2352x1568px. CFP — 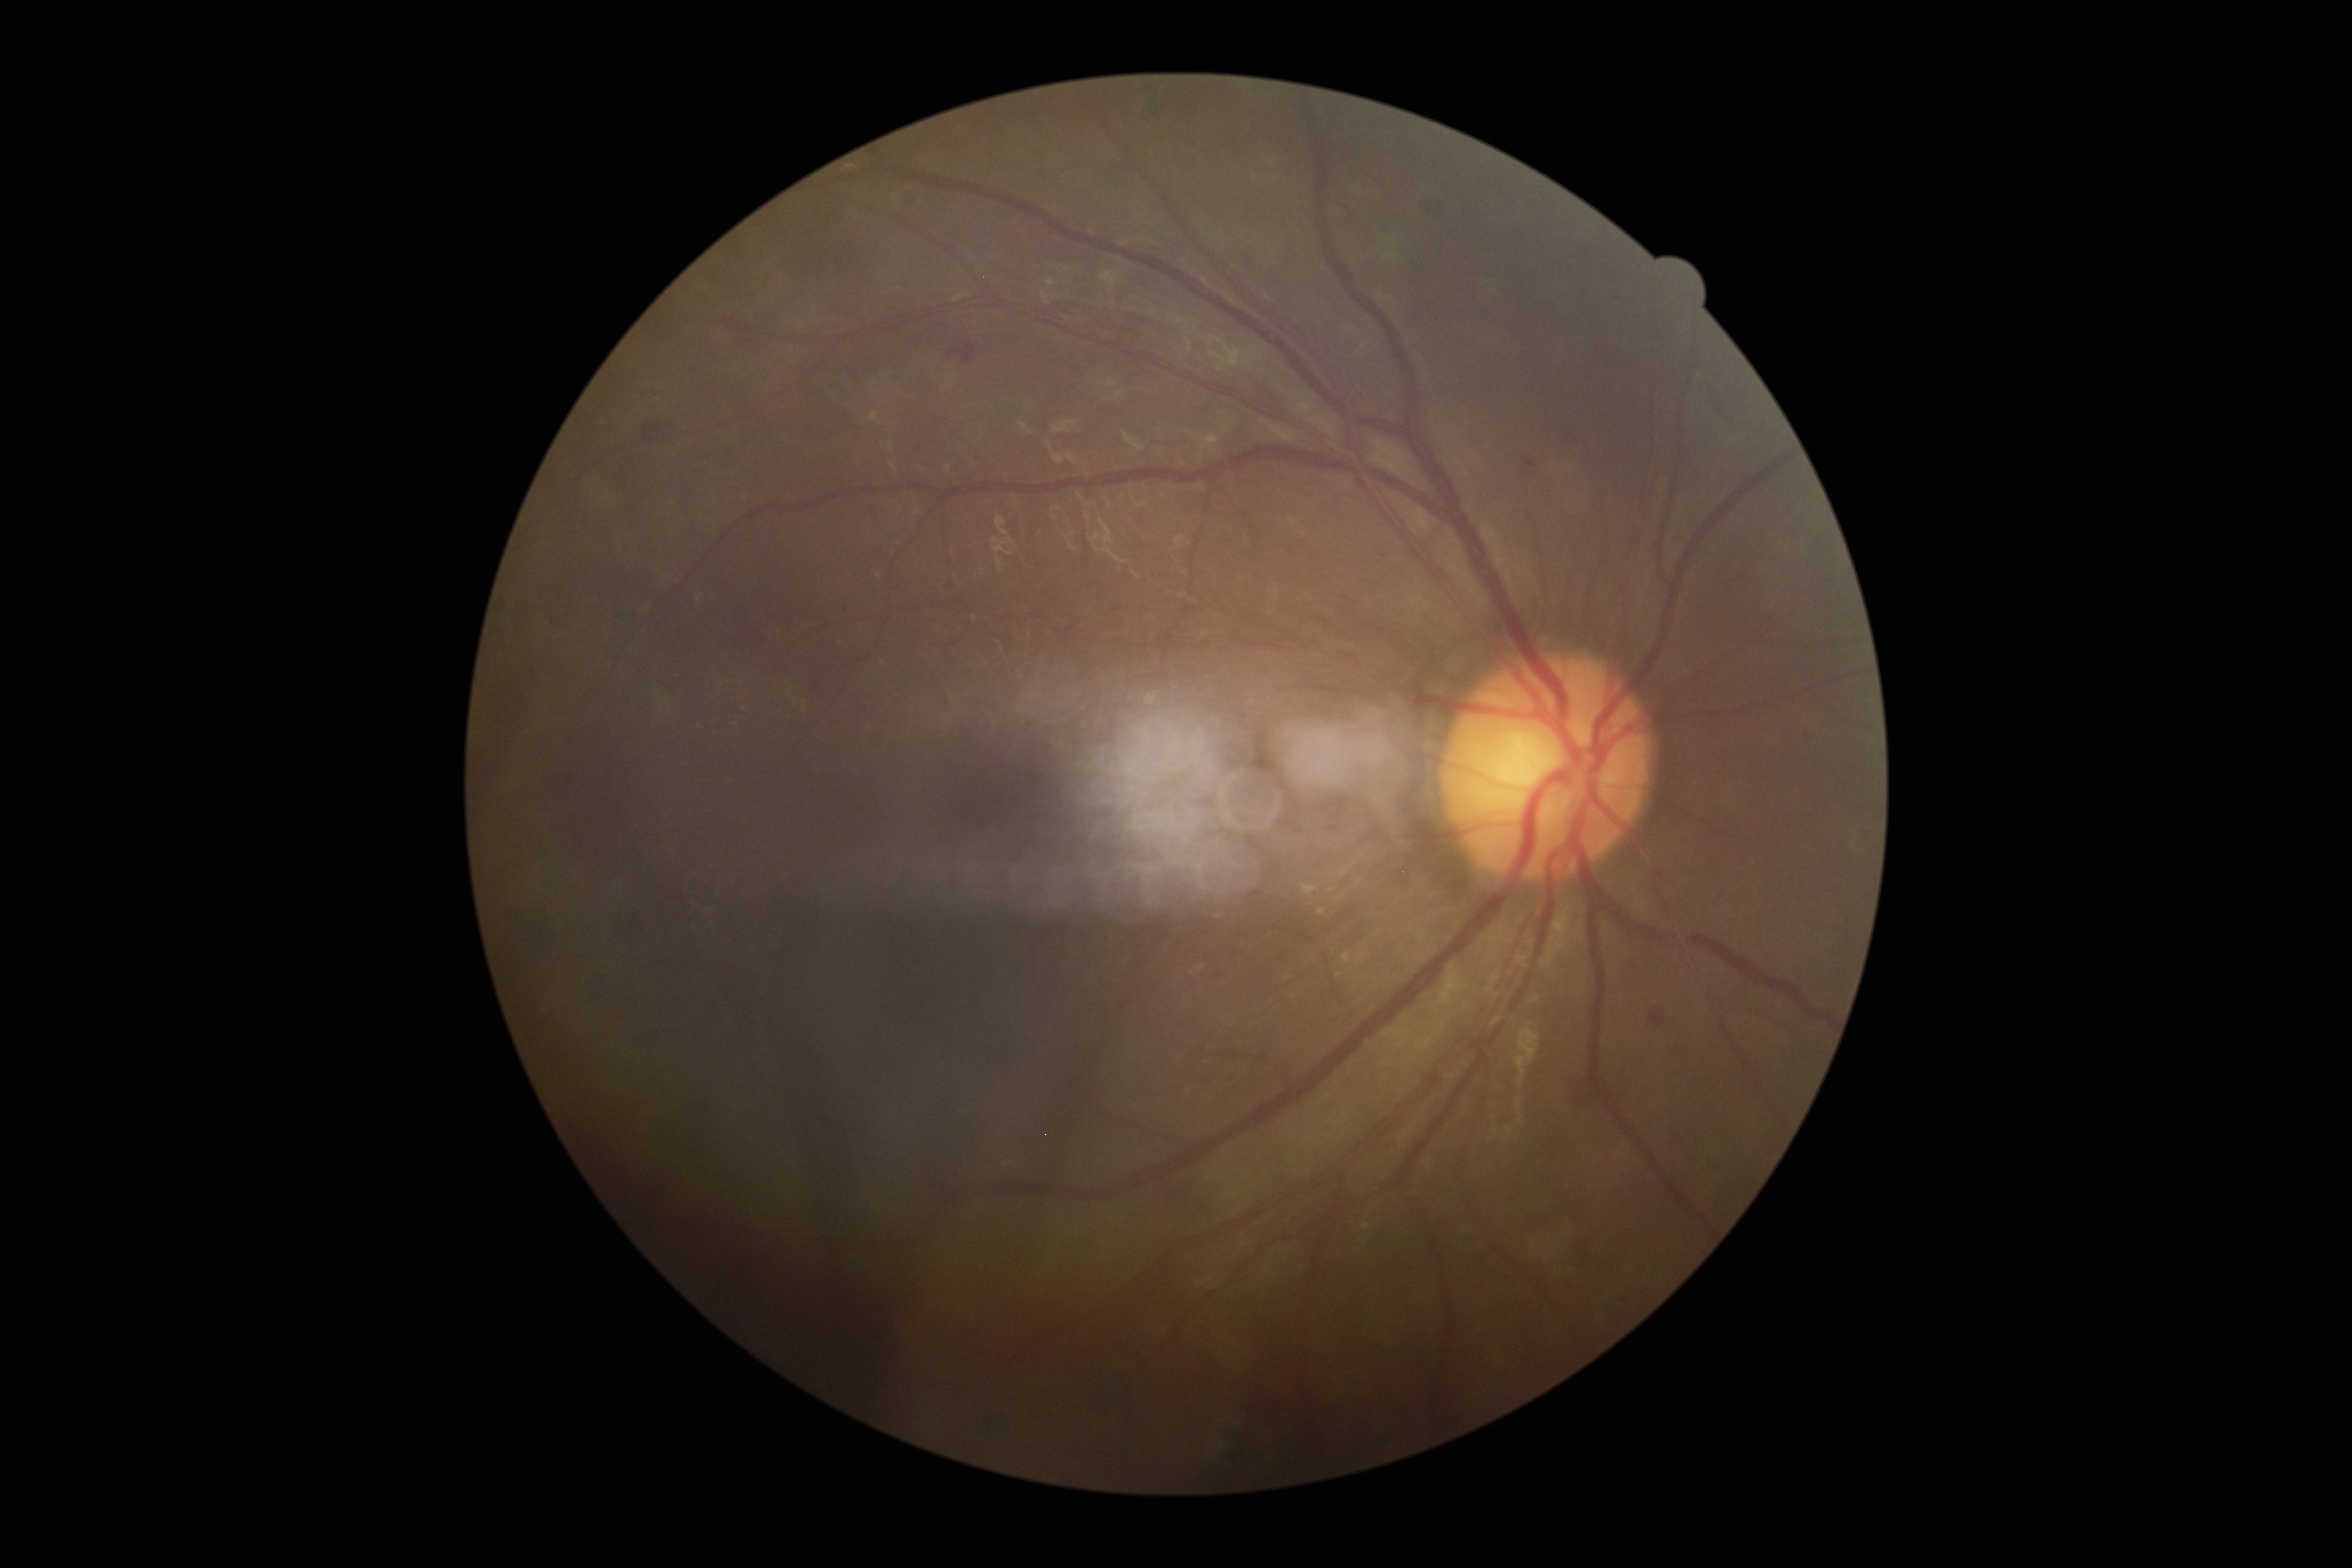 Diabetic retinopathy: grade 2 (moderate NPDR) — more than just microaneurysms but less than severe NPDR.